CFP. 45 degree fundus photograph. 848 x 848 pixels. Without pupil dilation
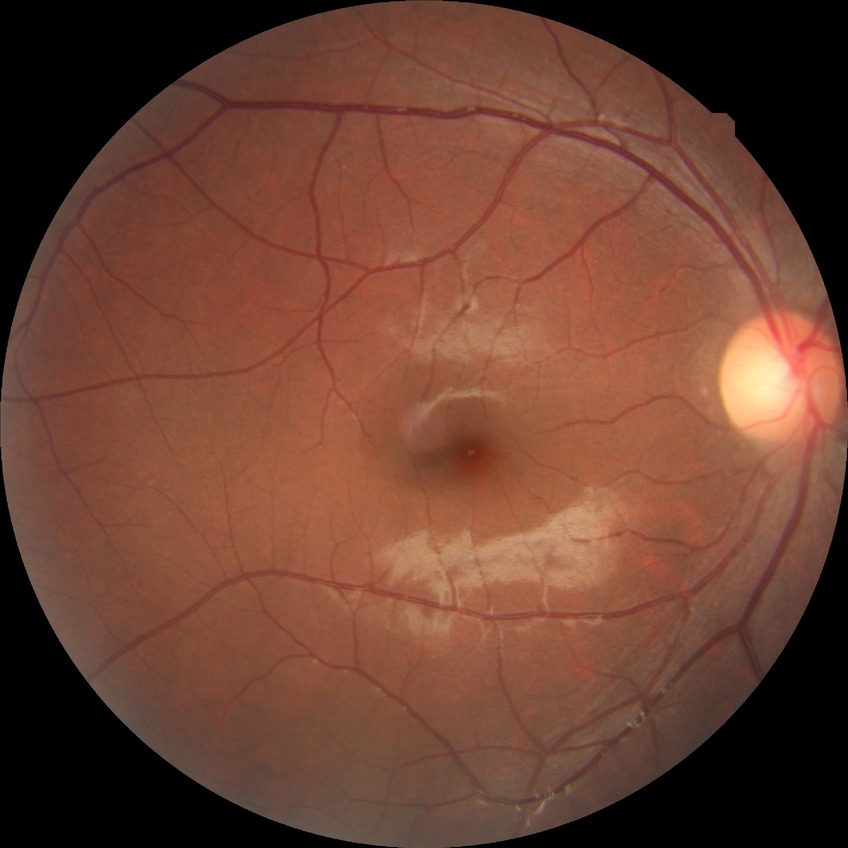
– Davis grading: no diabetic retinopathy